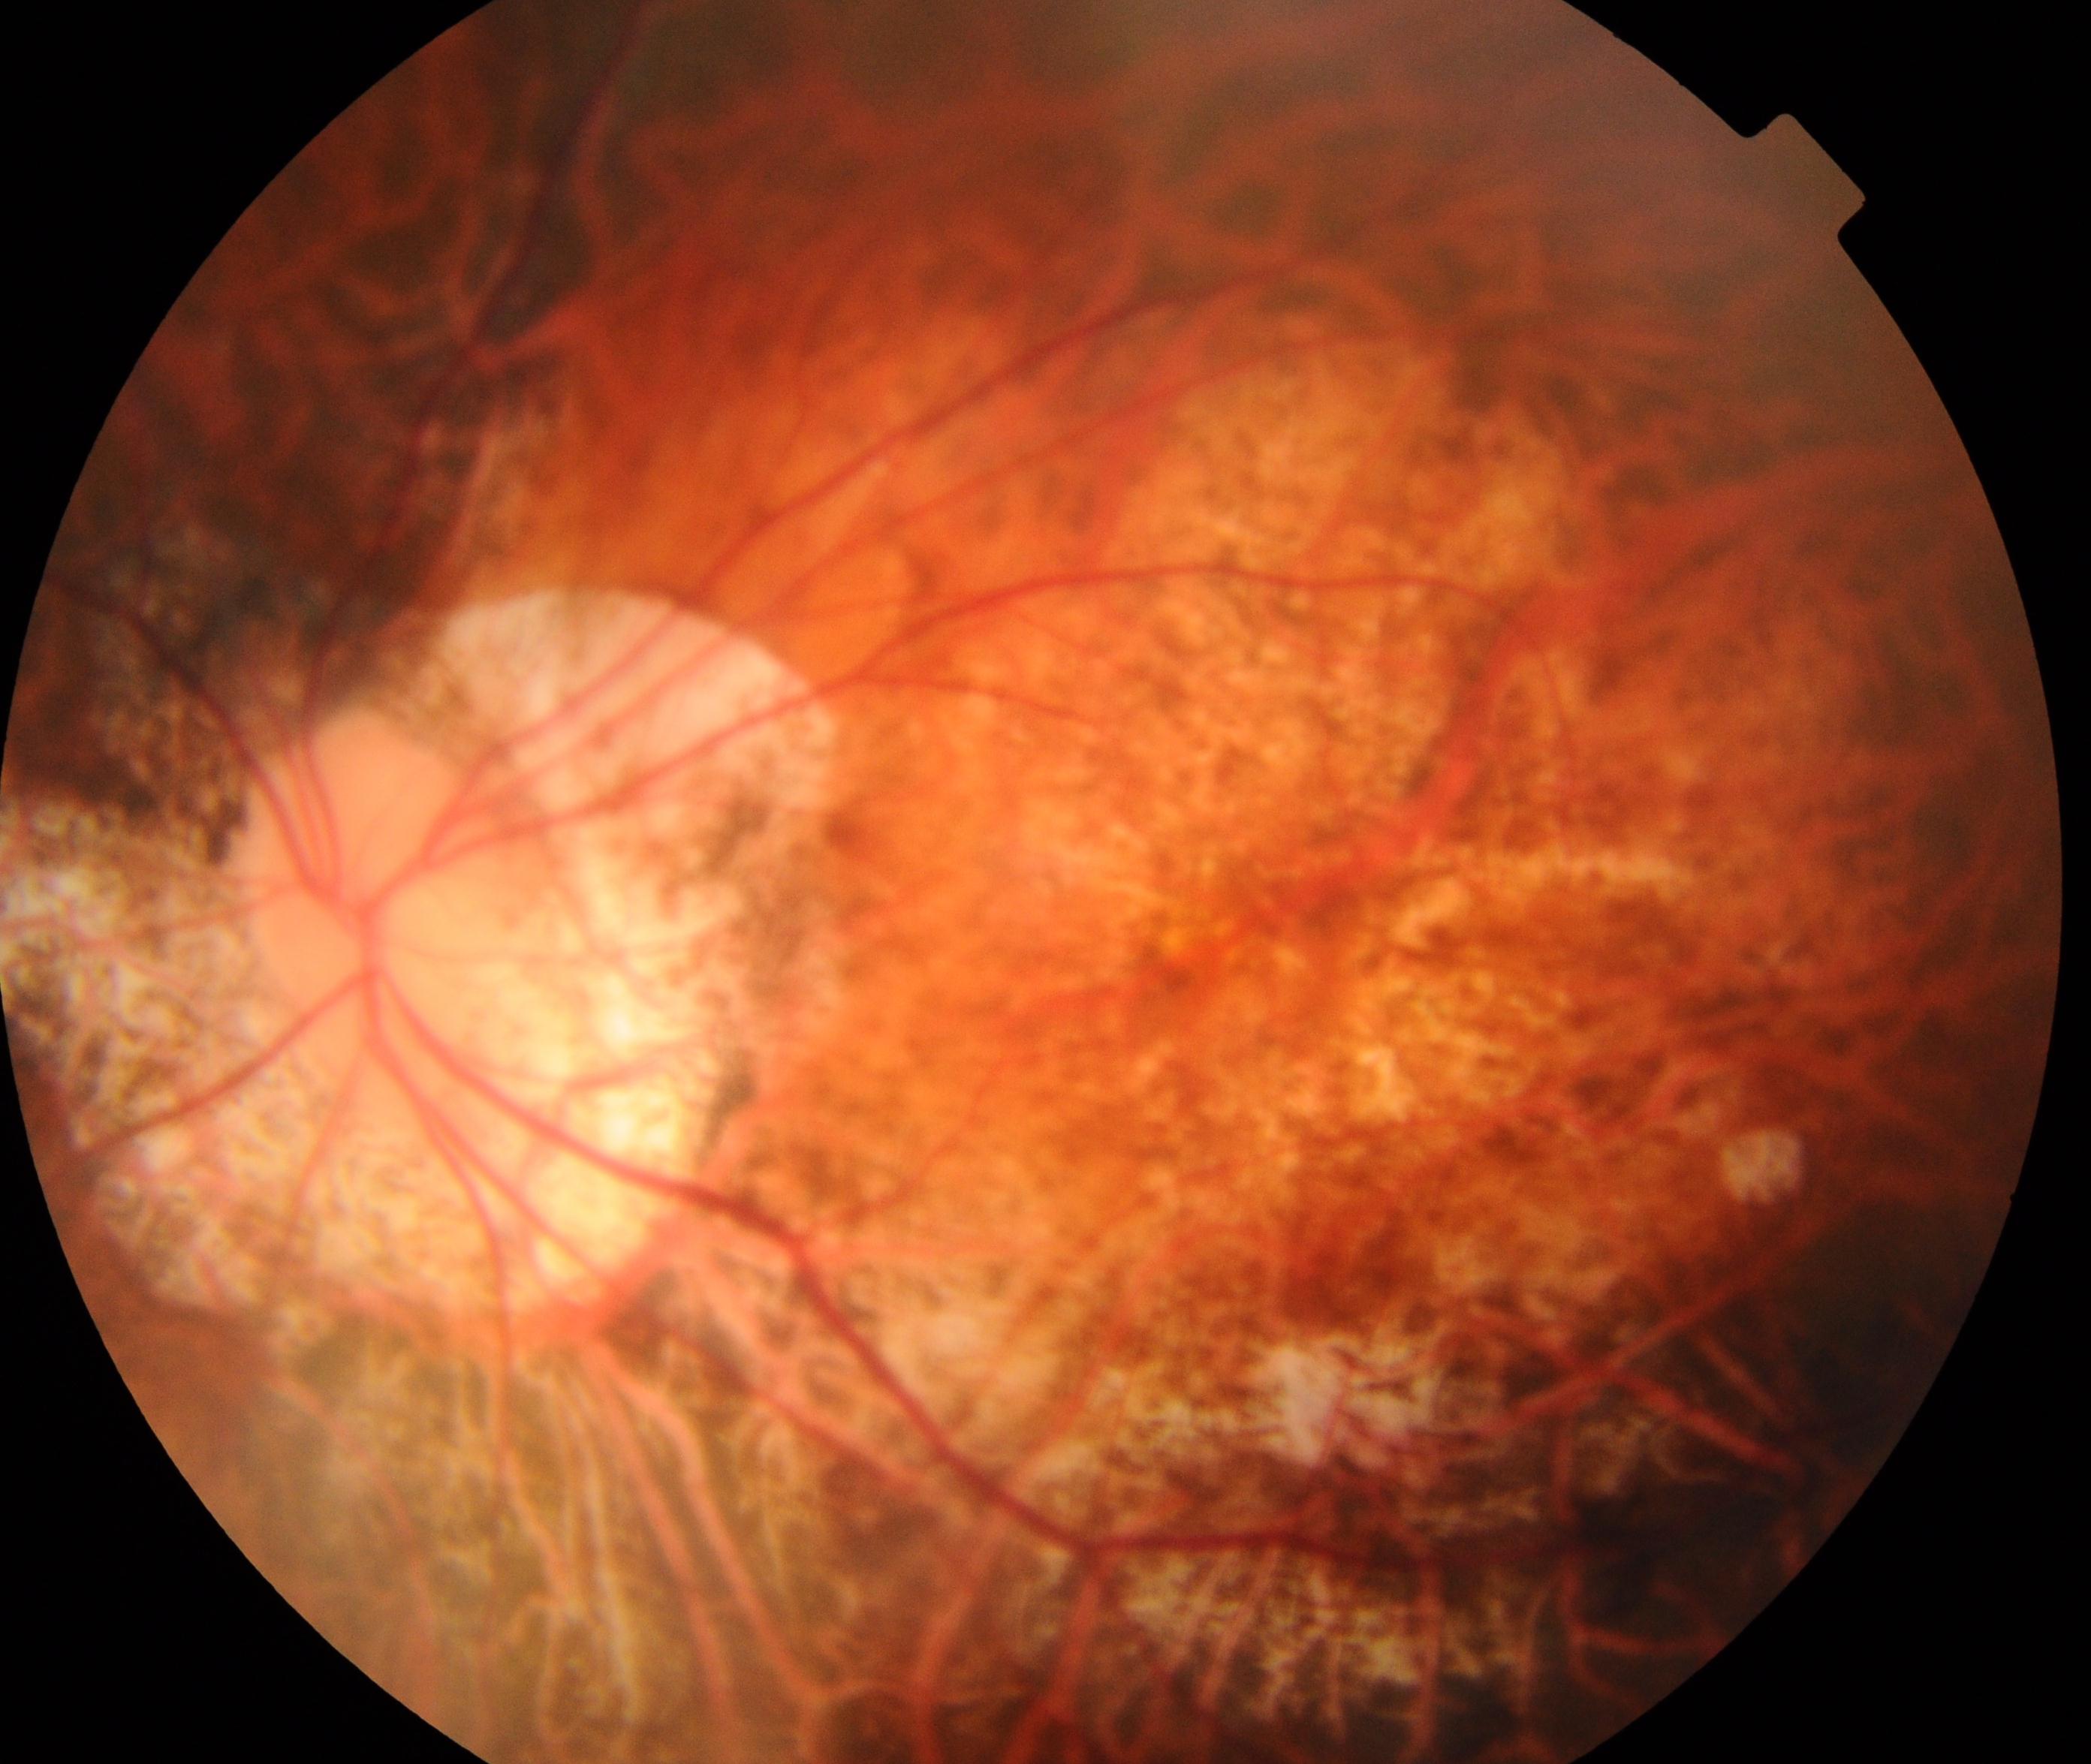 Consistent with pathological myopia.